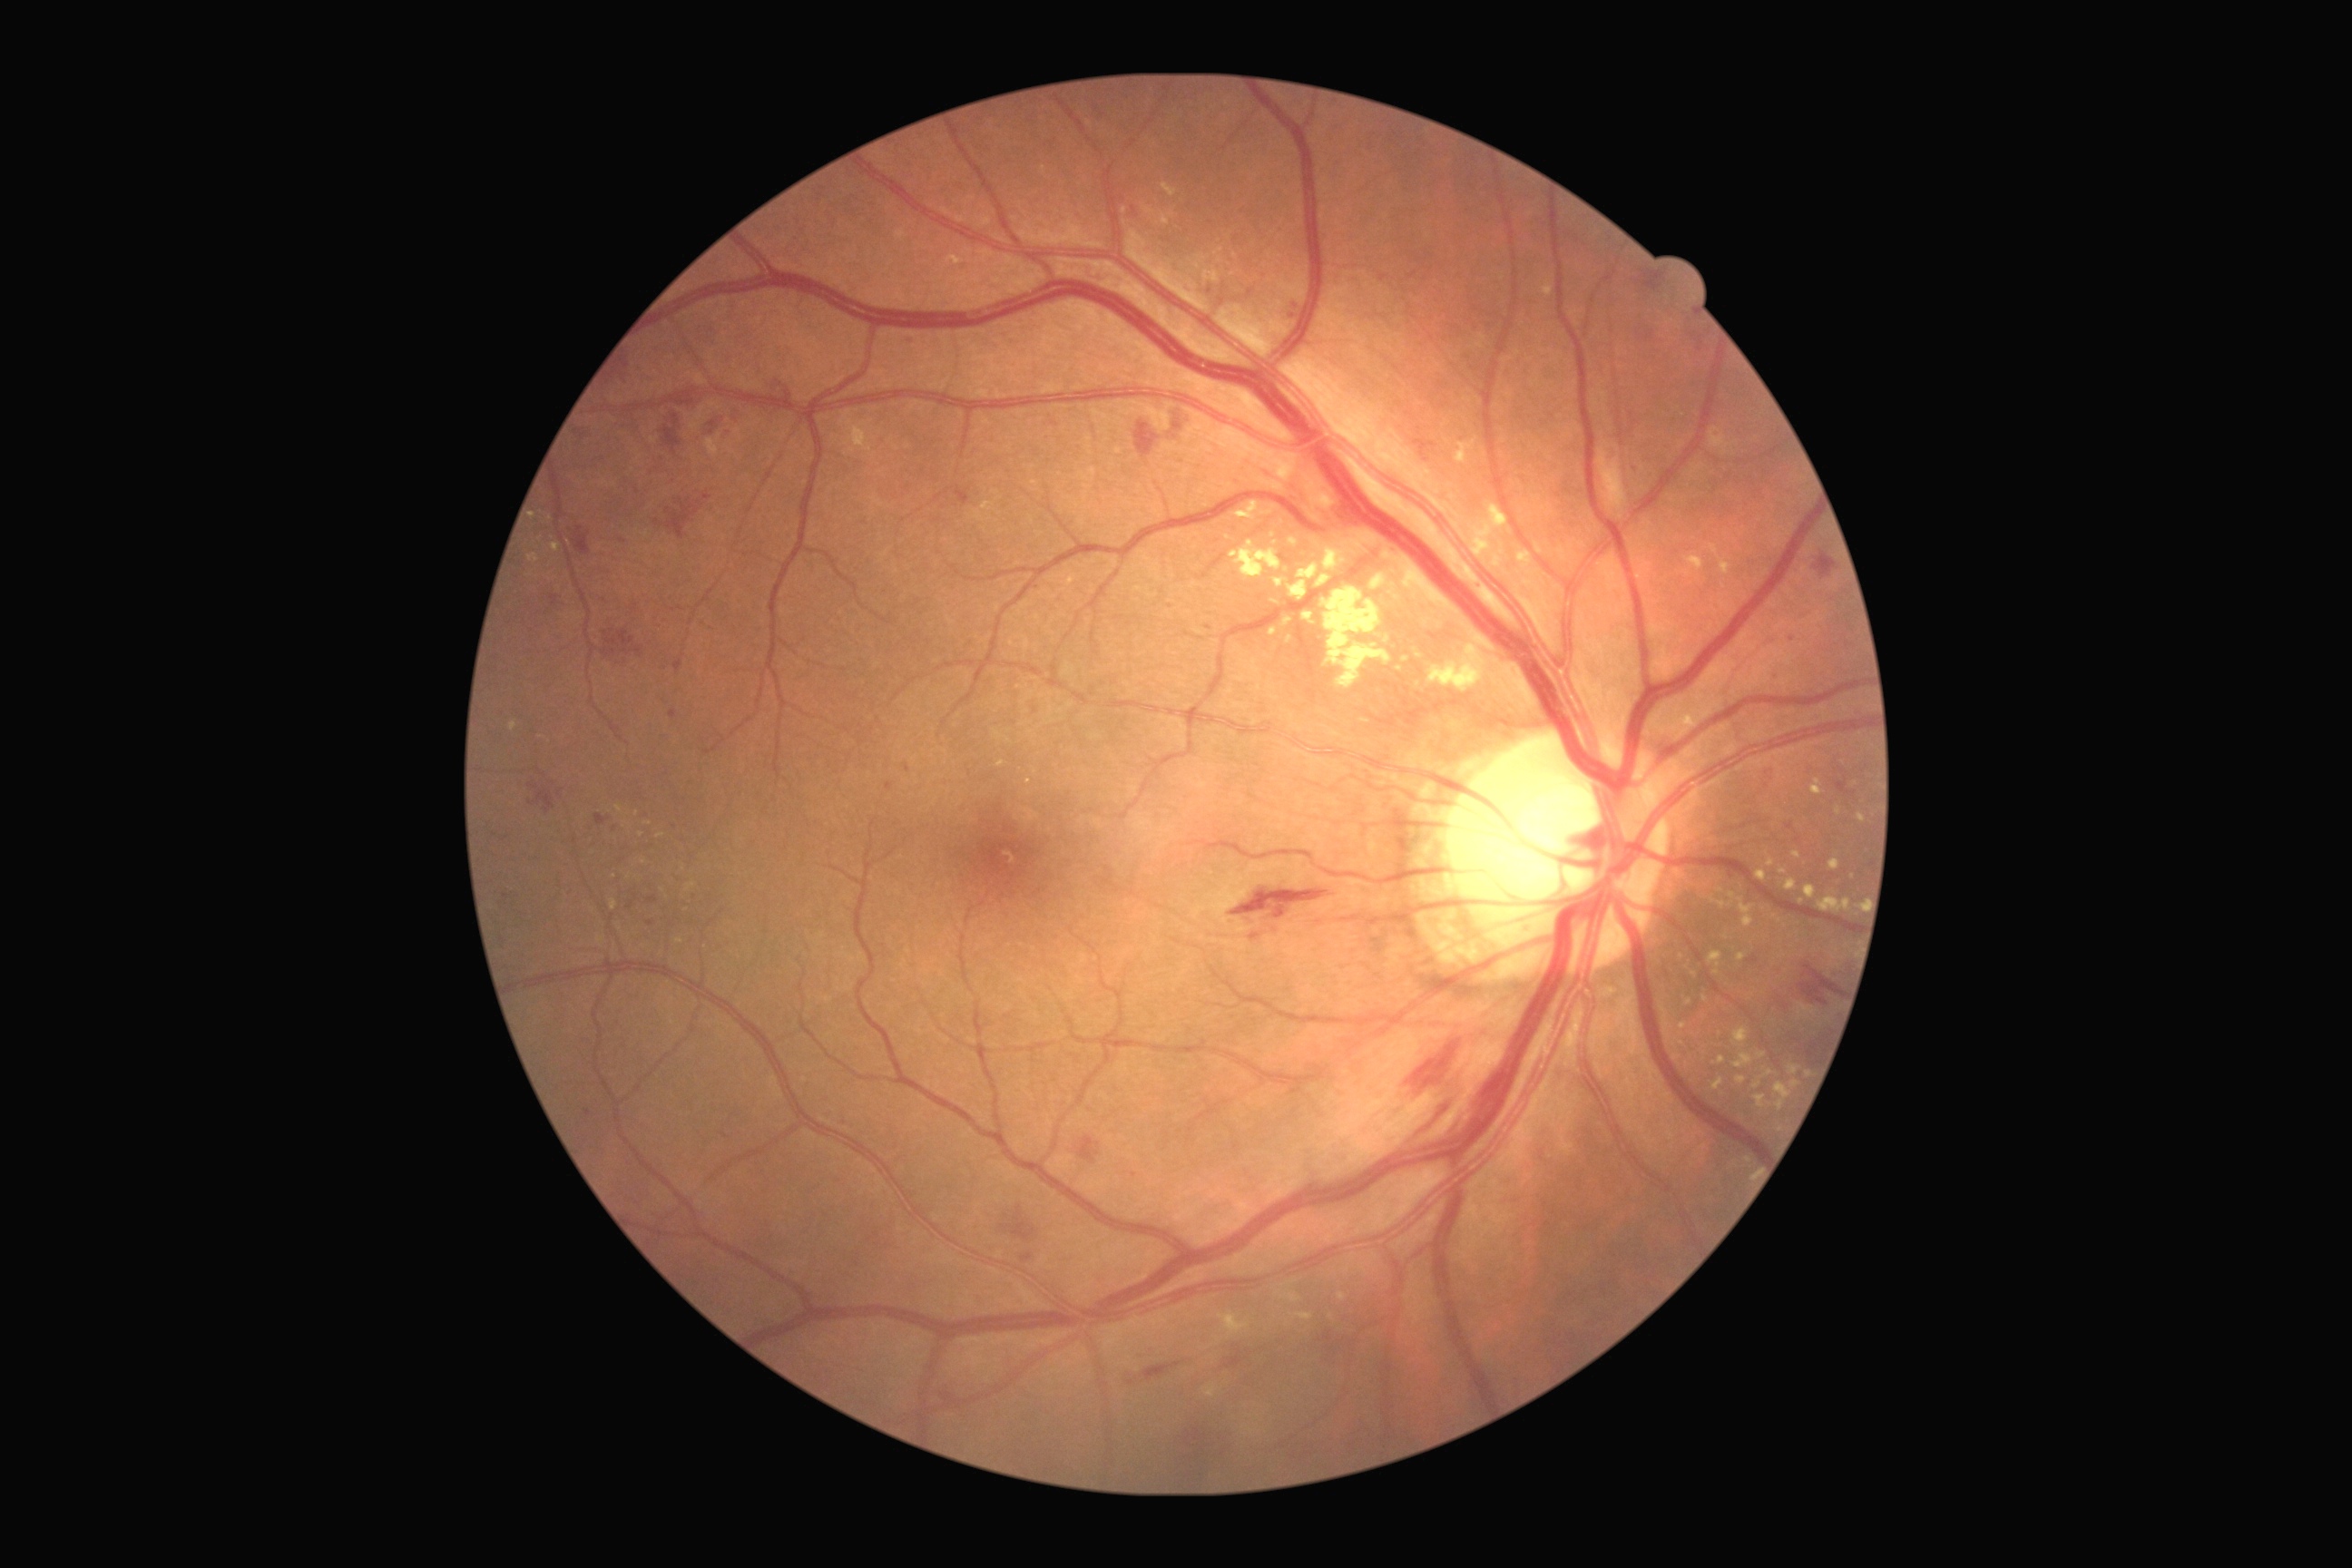 Diabetic retinopathy (DR) is 2/4 — more than just microaneurysms but less than severe NPDR; non-proliferative diabetic retinopathy
Selected lesions:
hemorrhages (HEs) (subset): {"x1": 1407, "y1": 1041, "x2": 1462, "y2": 1092}; {"x1": 1224, "y1": 1348, "x2": 1244, "y2": 1369}; {"x1": 1001, "y1": 1206, "x2": 1037, "y2": 1242}; {"x1": 1411, "y1": 1095, "x2": 1460, "y2": 1137}; {"x1": 529, "y1": 783, "x2": 556, "y2": 814}; {"x1": 602, "y1": 647, "x2": 618, "y2": 658}; {"x1": 1634, "y1": 270, "x2": 1667, "y2": 293}; {"x1": 662, "y1": 413, "x2": 683, "y2": 456}; {"x1": 774, "y1": 380, "x2": 792, "y2": 398}; {"x1": 1021, "y1": 1253, "x2": 1034, "y2": 1262}; {"x1": 571, "y1": 525, "x2": 591, "y2": 556}; {"x1": 1079, "y1": 1137, "x2": 1101, "y2": 1164}; {"x1": 647, "y1": 896, "x2": 658, "y2": 905}
hard exudates (EXs) (subset): {"x1": 1230, "y1": 540, "x2": 1282, "y2": 580}; {"x1": 1162, "y1": 184, "x2": 1177, "y2": 197}; {"x1": 983, "y1": 502, "x2": 994, "y2": 513}; {"x1": 1767, "y1": 859, "x2": 1776, "y2": 867}; {"x1": 1206, "y1": 1386, "x2": 1217, "y2": 1398}; {"x1": 1818, "y1": 897, "x2": 1852, "y2": 914}; {"x1": 1714, "y1": 1057, "x2": 1727, "y2": 1064}; {"x1": 1518, "y1": 549, "x2": 1533, "y2": 571}; {"x1": 1732, "y1": 1028, "x2": 1750, "y2": 1050}; {"x1": 1295, "y1": 1313, "x2": 1313, "y2": 1322}; {"x1": 1273, "y1": 580, "x2": 1284, "y2": 587}; {"x1": 553, "y1": 544, "x2": 560, "y2": 553}; {"x1": 1736, "y1": 1075, "x2": 1747, "y2": 1084}
Smaller EXs around (621,930); (641,835); (1001,764); (1273,536); (1797,855); (679,942)
microaneurysms (MAs) (subset): {"x1": 887, "y1": 783, "x2": 894, "y2": 792}; {"x1": 1631, "y1": 466, "x2": 1640, "y2": 471}; {"x1": 1132, "y1": 1171, "x2": 1139, "y2": 1179}
Smaller MAs around (1460,449); (1208,628); (1209,291); (623,541); (615,829); (1793,640); (1462,439); (650,923)